CFP.
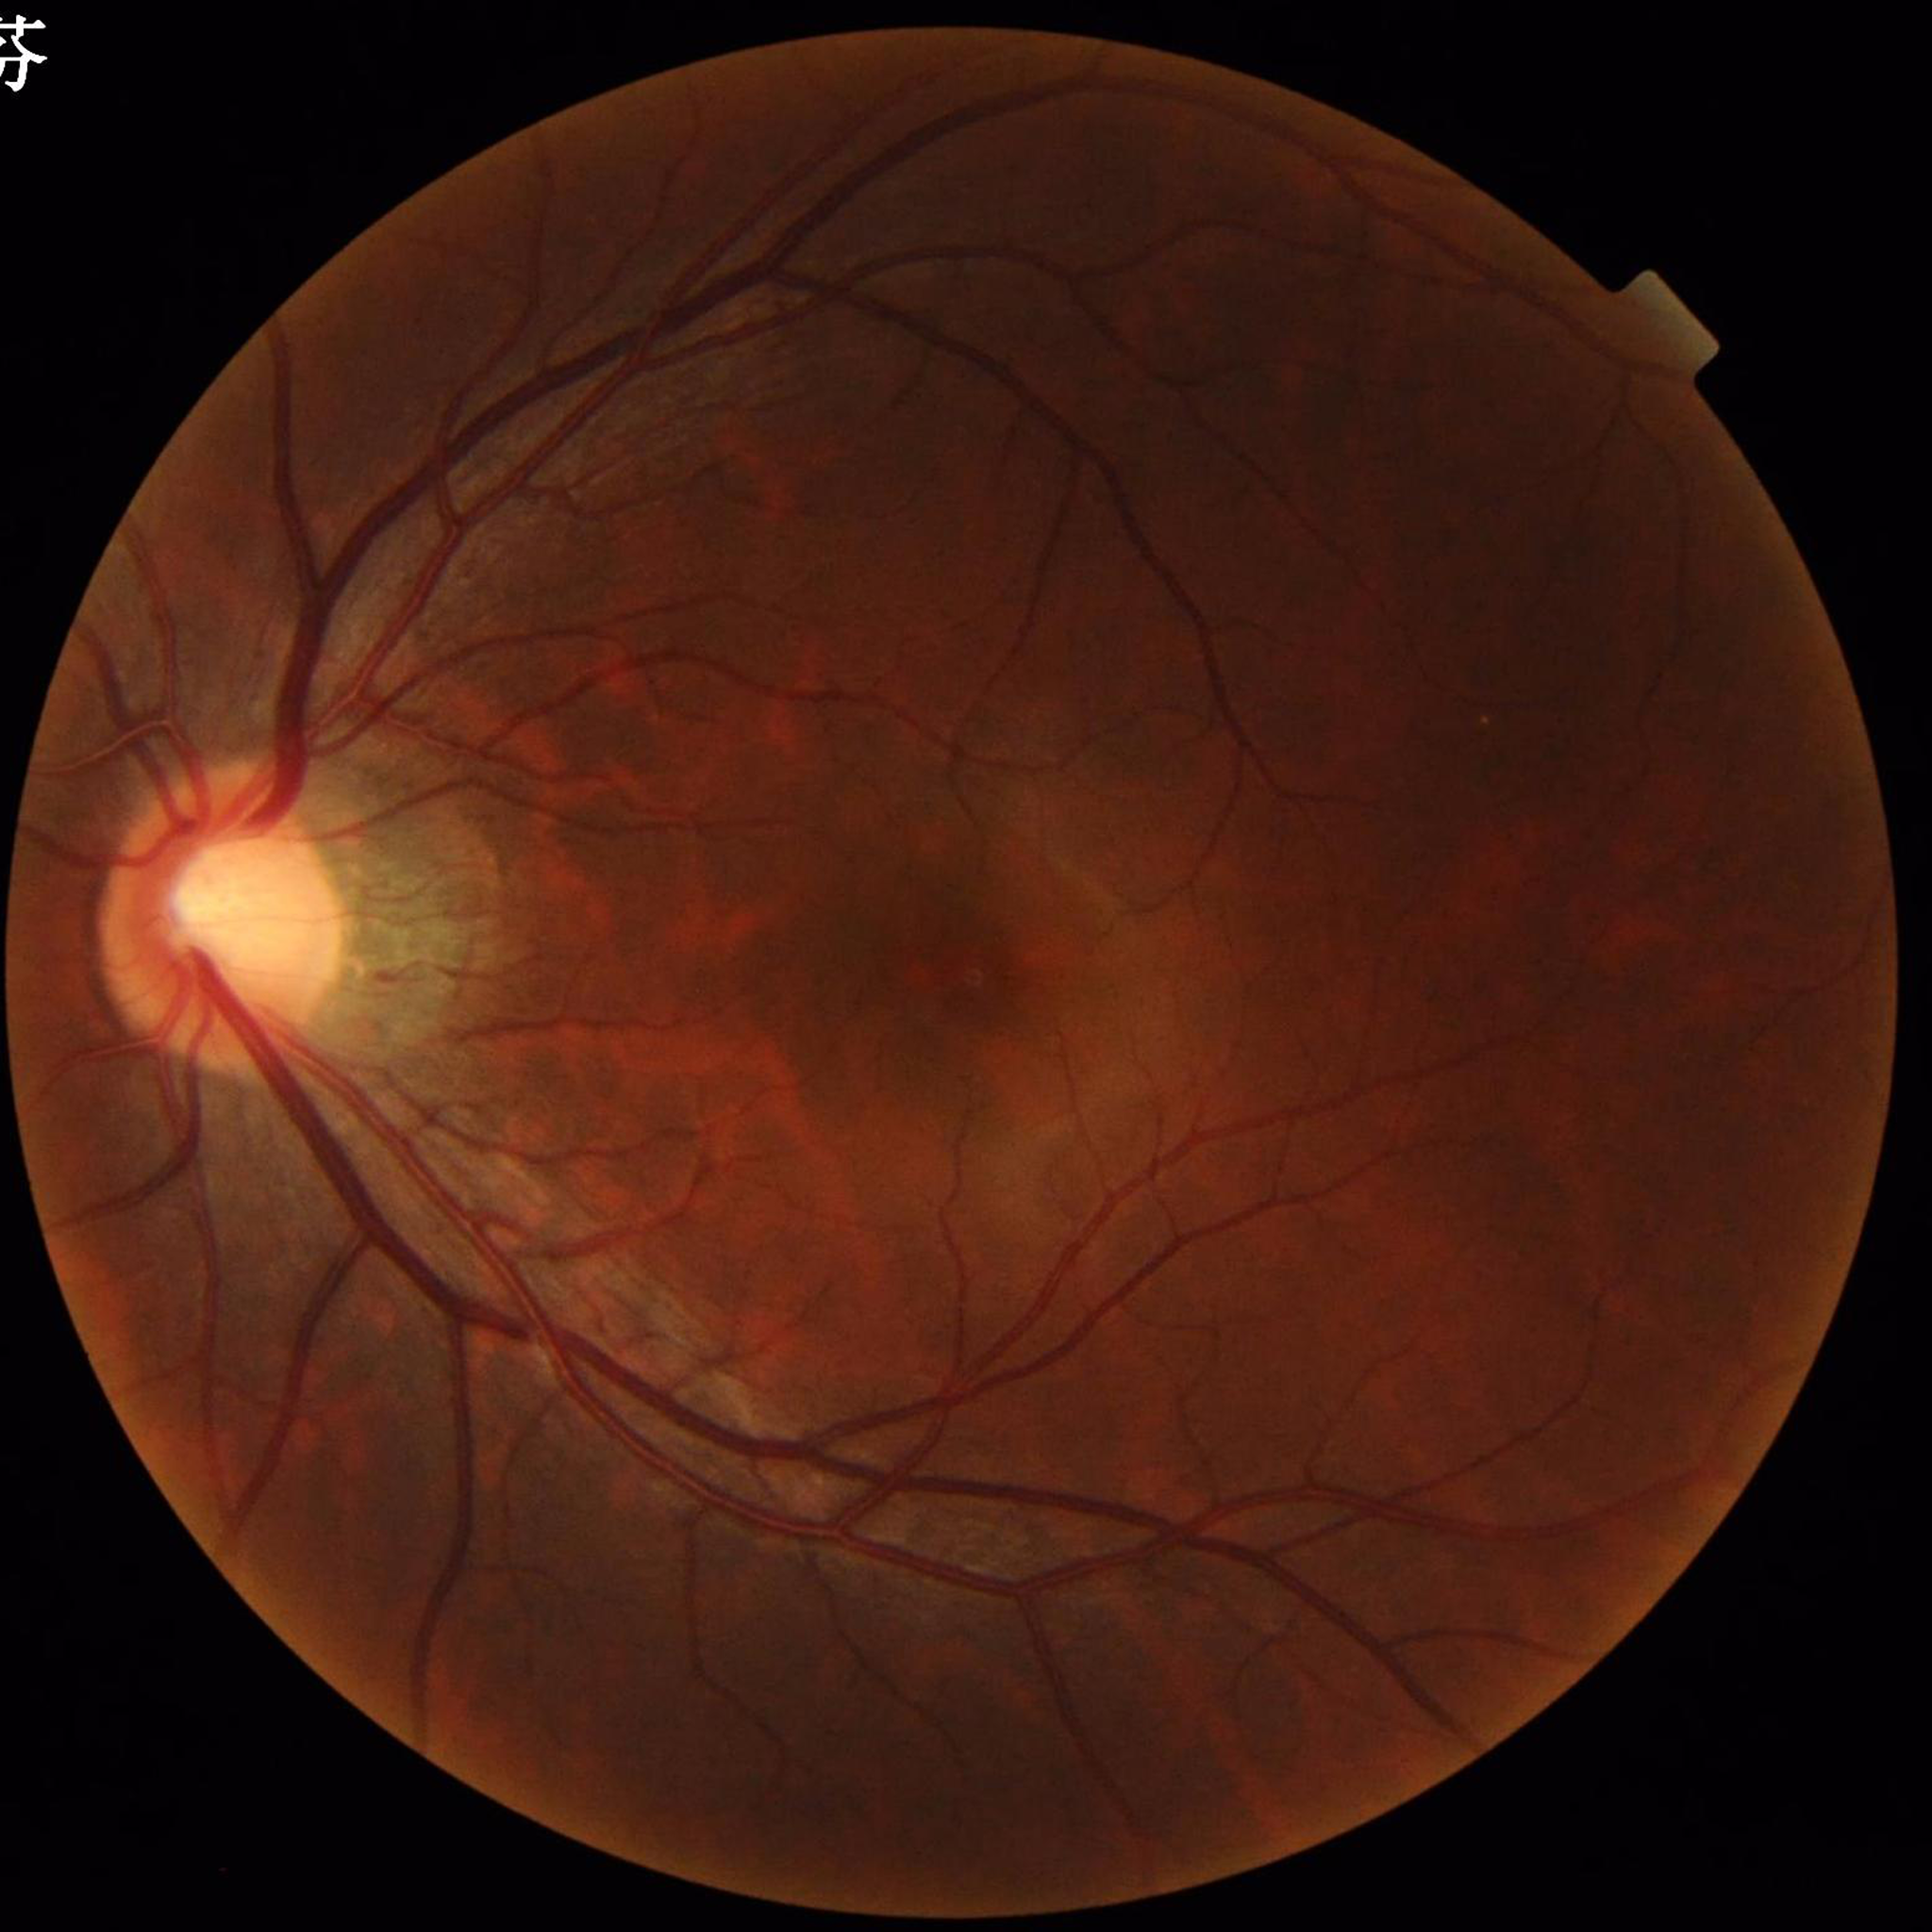
  diagnosis: no AMD, DR, or glaucomatous findings